1240 by 1240 pixels · wide-field fundus image from infant ROP screening.
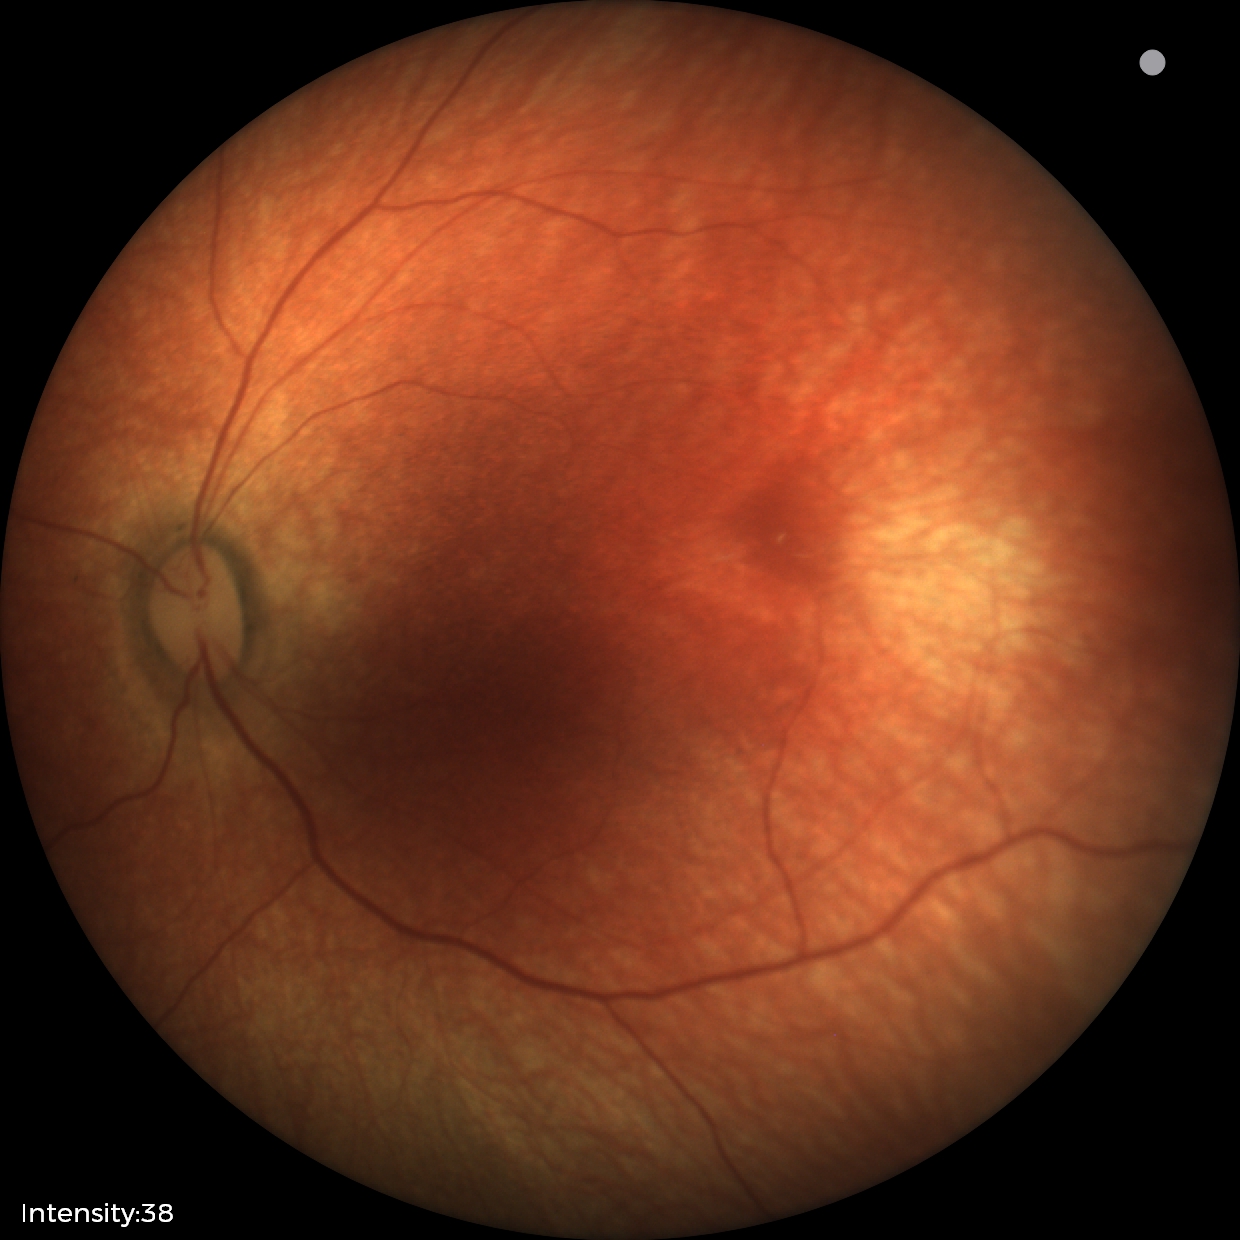

Finding = physiological appearance